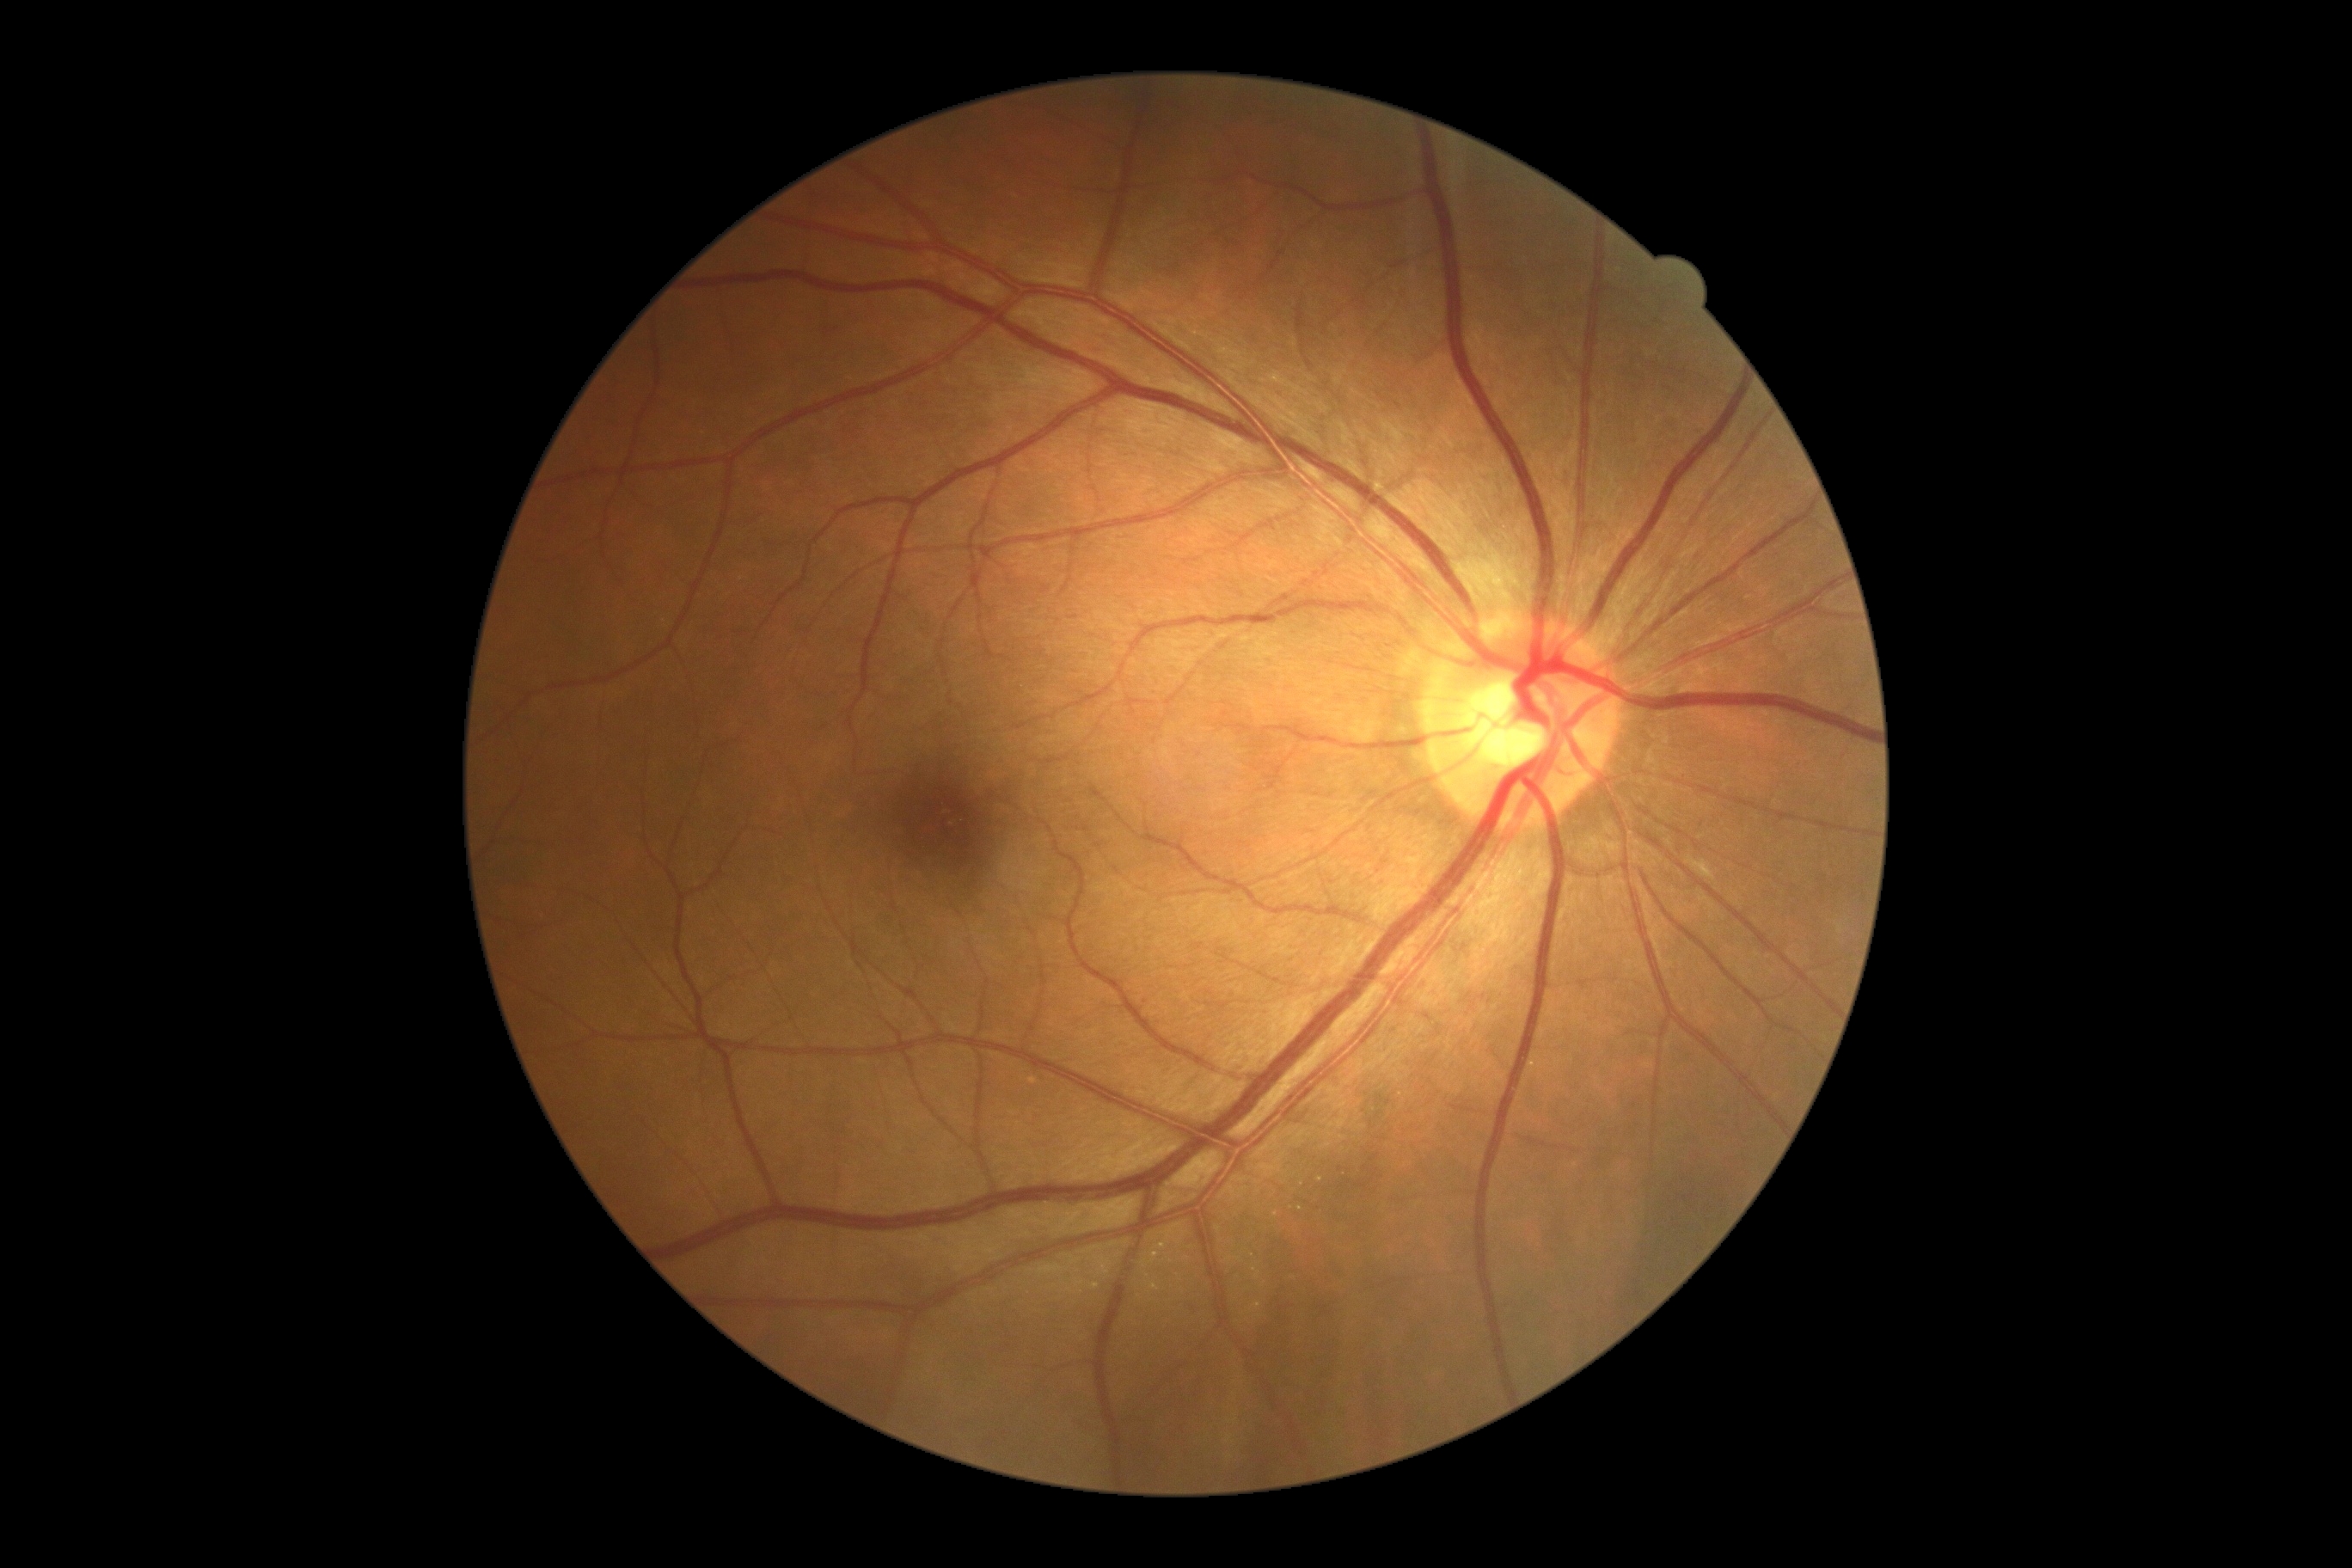

DR severity: 0/4.